No pharmacologic dilation · camera: NIDEK AFC-230 · 45-degree field of view.
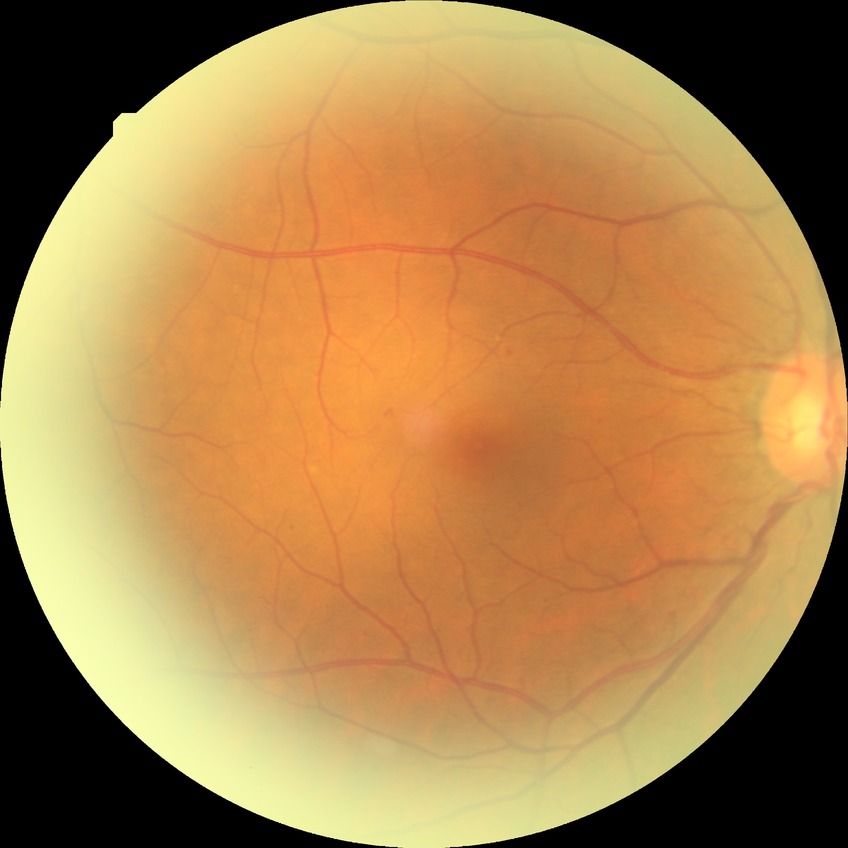   davis_grade: simple diabetic retinopathy